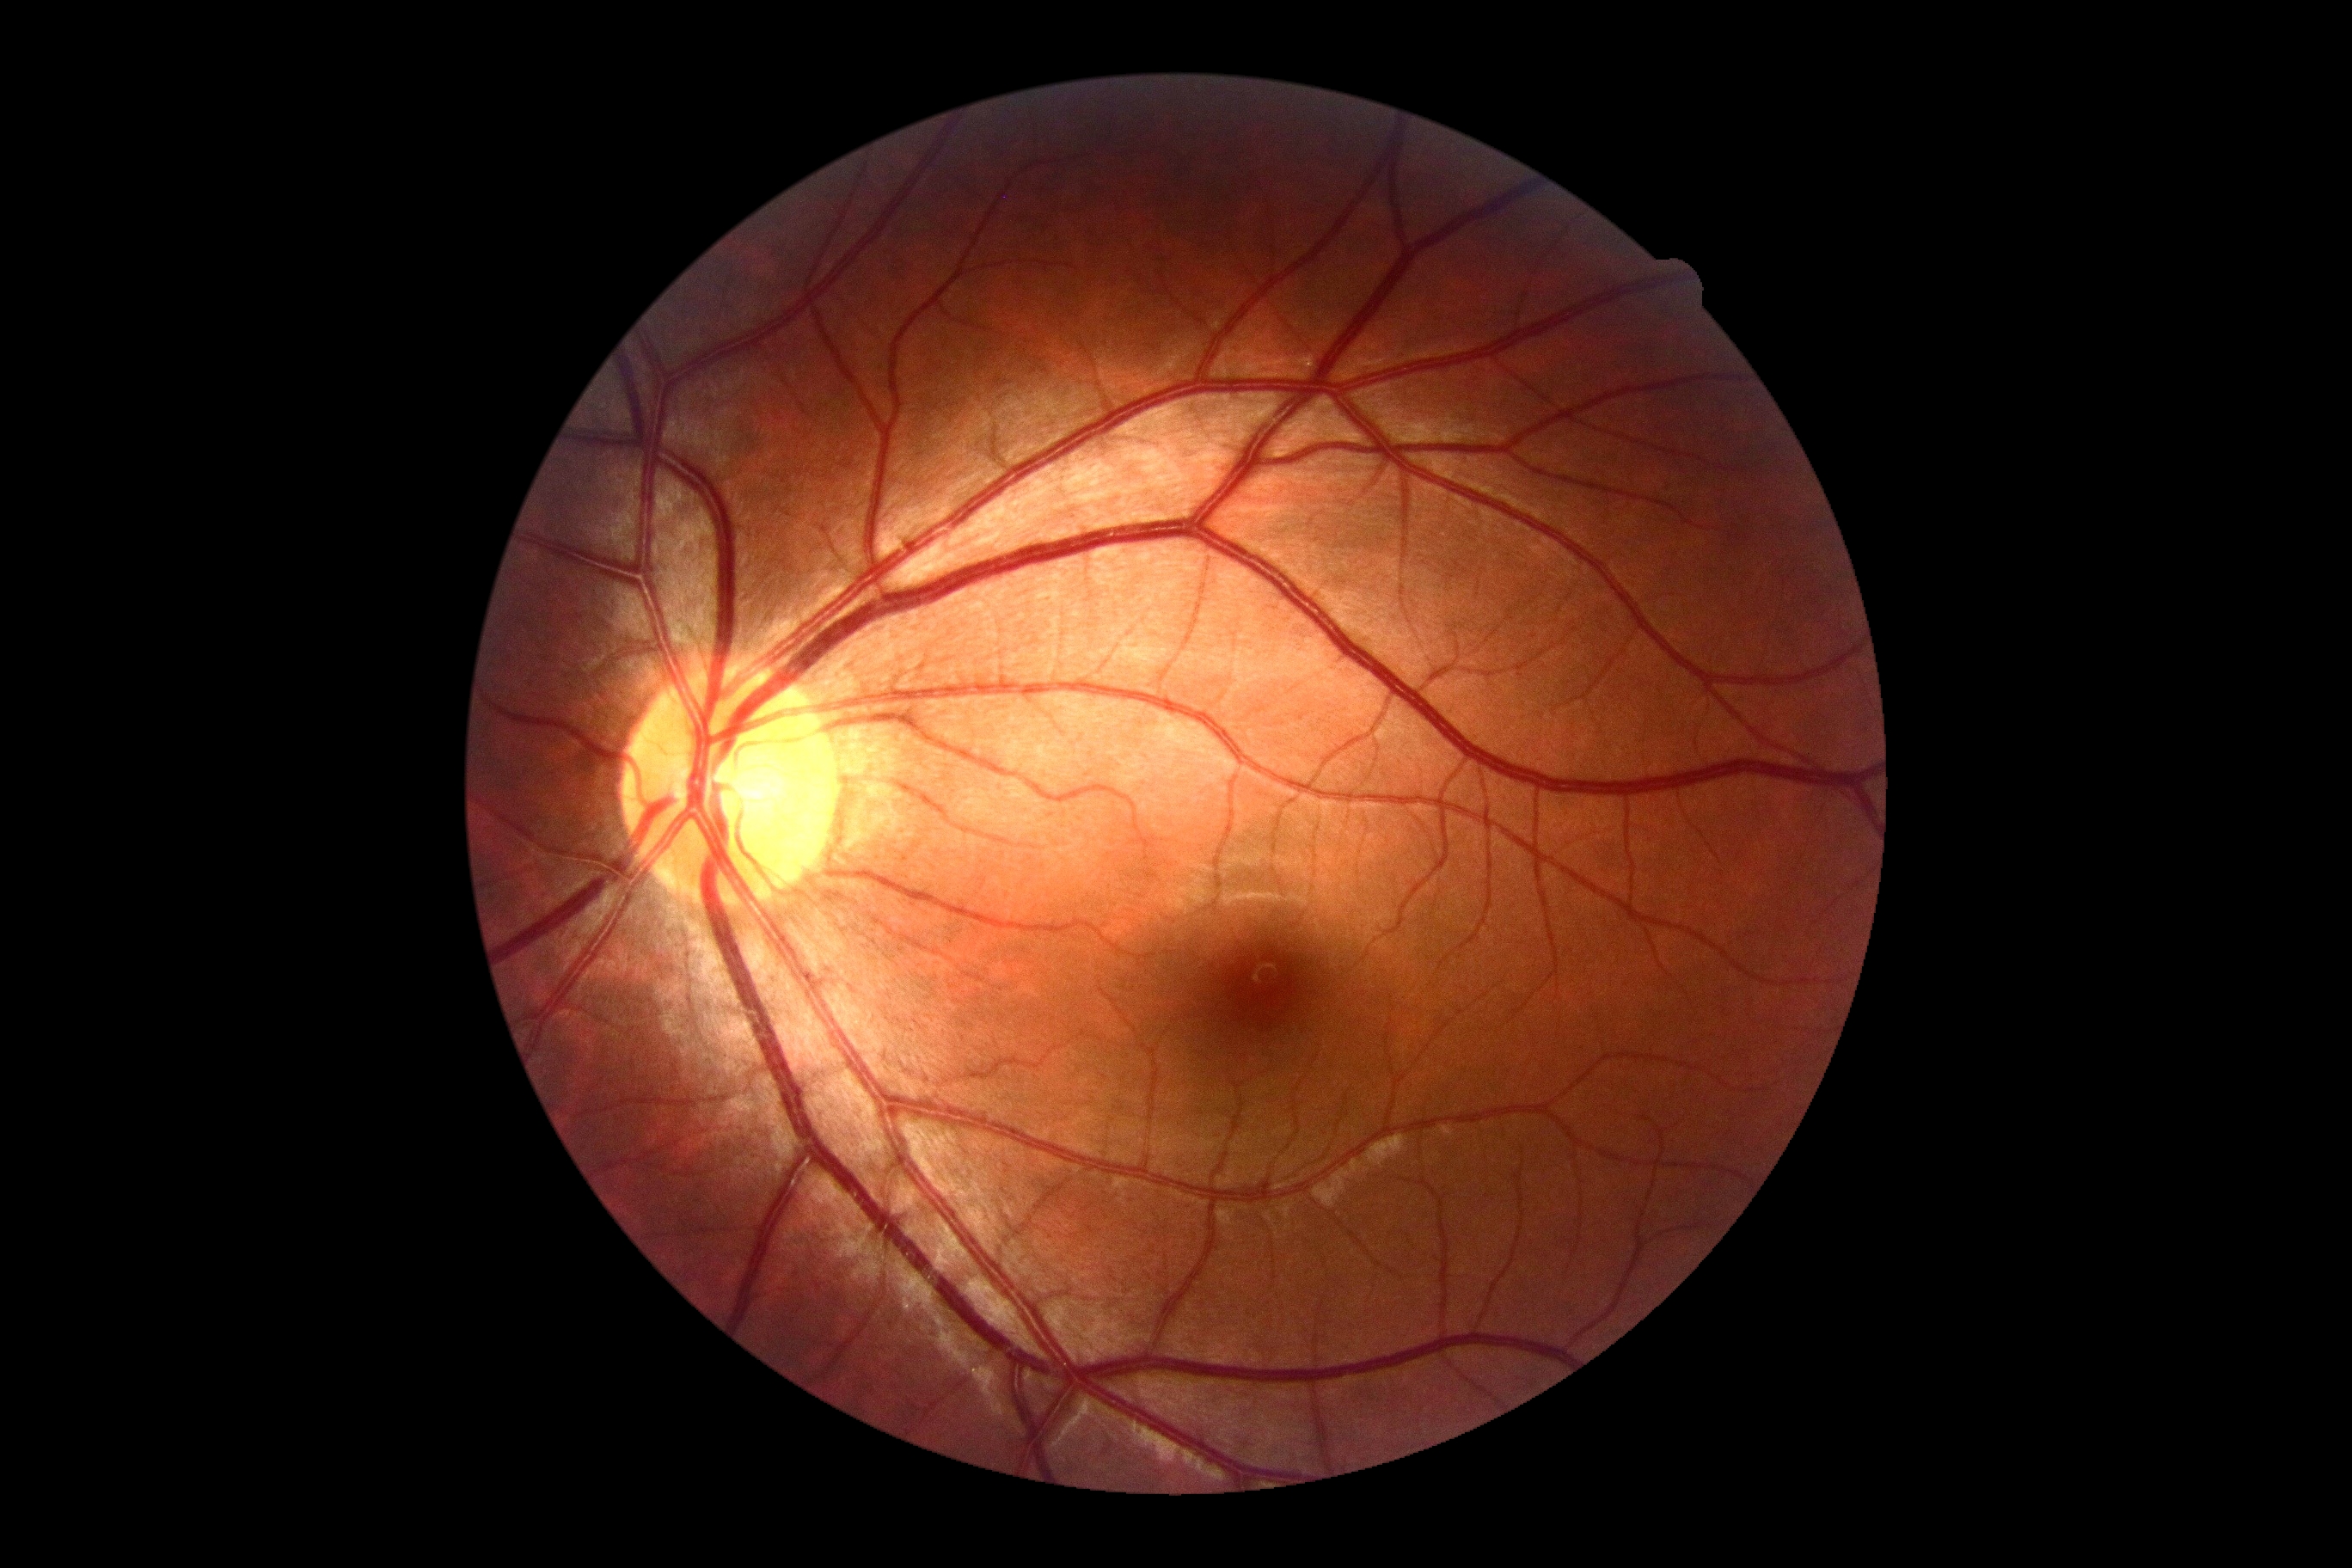 Diabetic retinopathy (DR): grade 0 (no apparent retinopathy).